Modified Davis grading.
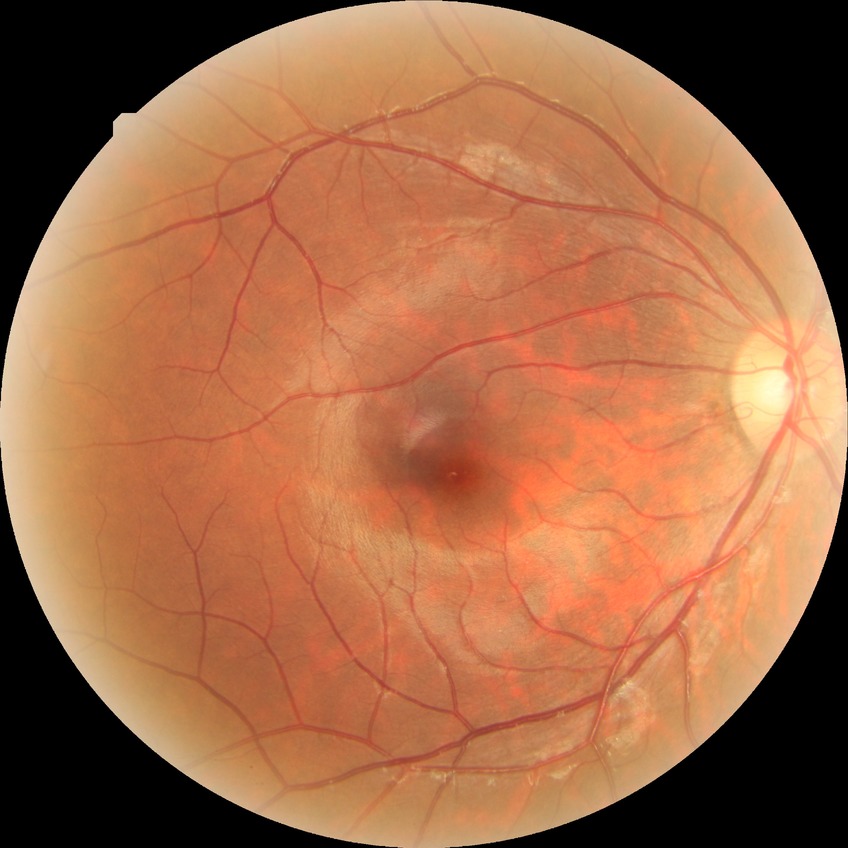
Diabetic retinopathy (DR) is no diabetic retinopathy (NDR).